Modified Davis grading, CFP: 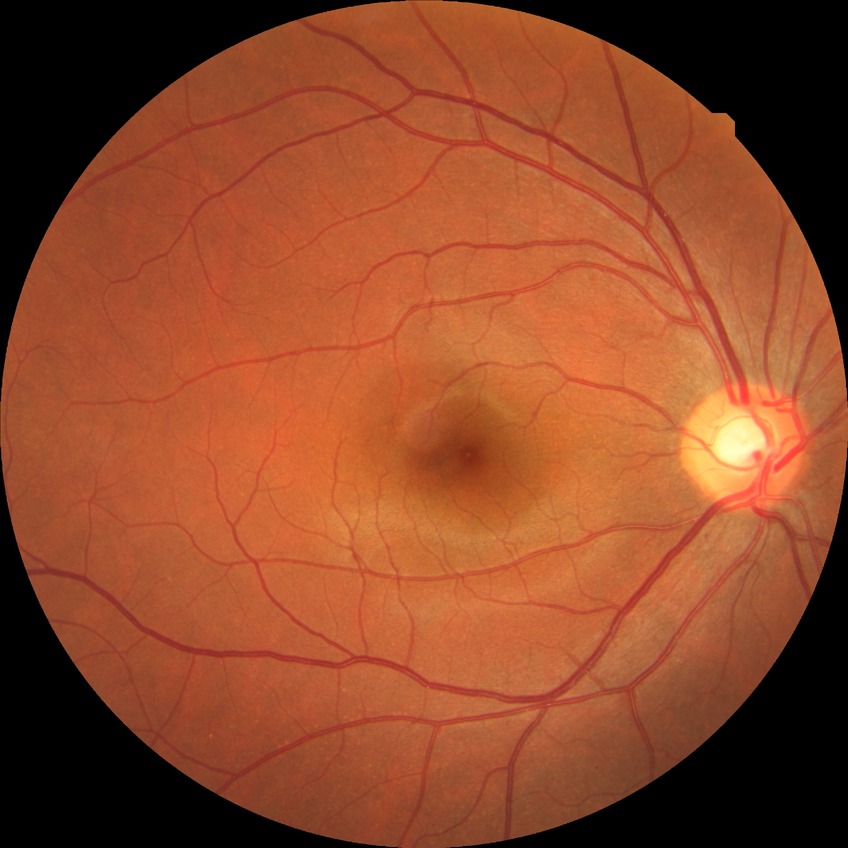

{"davis_grade": "NDR (no diabetic retinopathy)"}